640x480. Wide-field fundus photograph from neonatal ROP screening. Captured with the Clarity RetCam 3 (130° field of view):
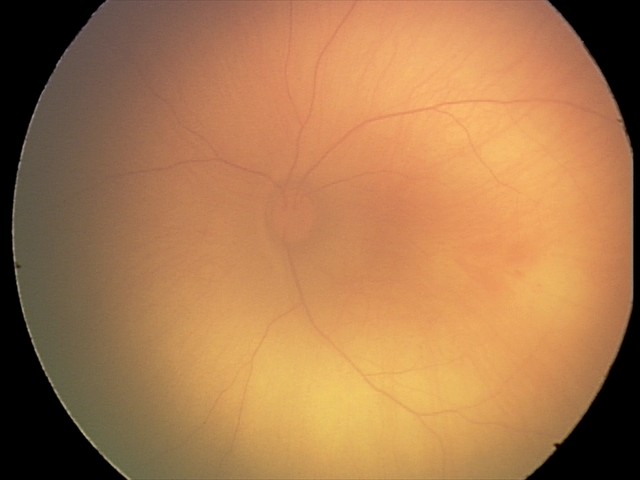 Finding = retinal hemorrhages.